2212 by 1659 pixels, color fundus photograph, FOV: 45 degrees — 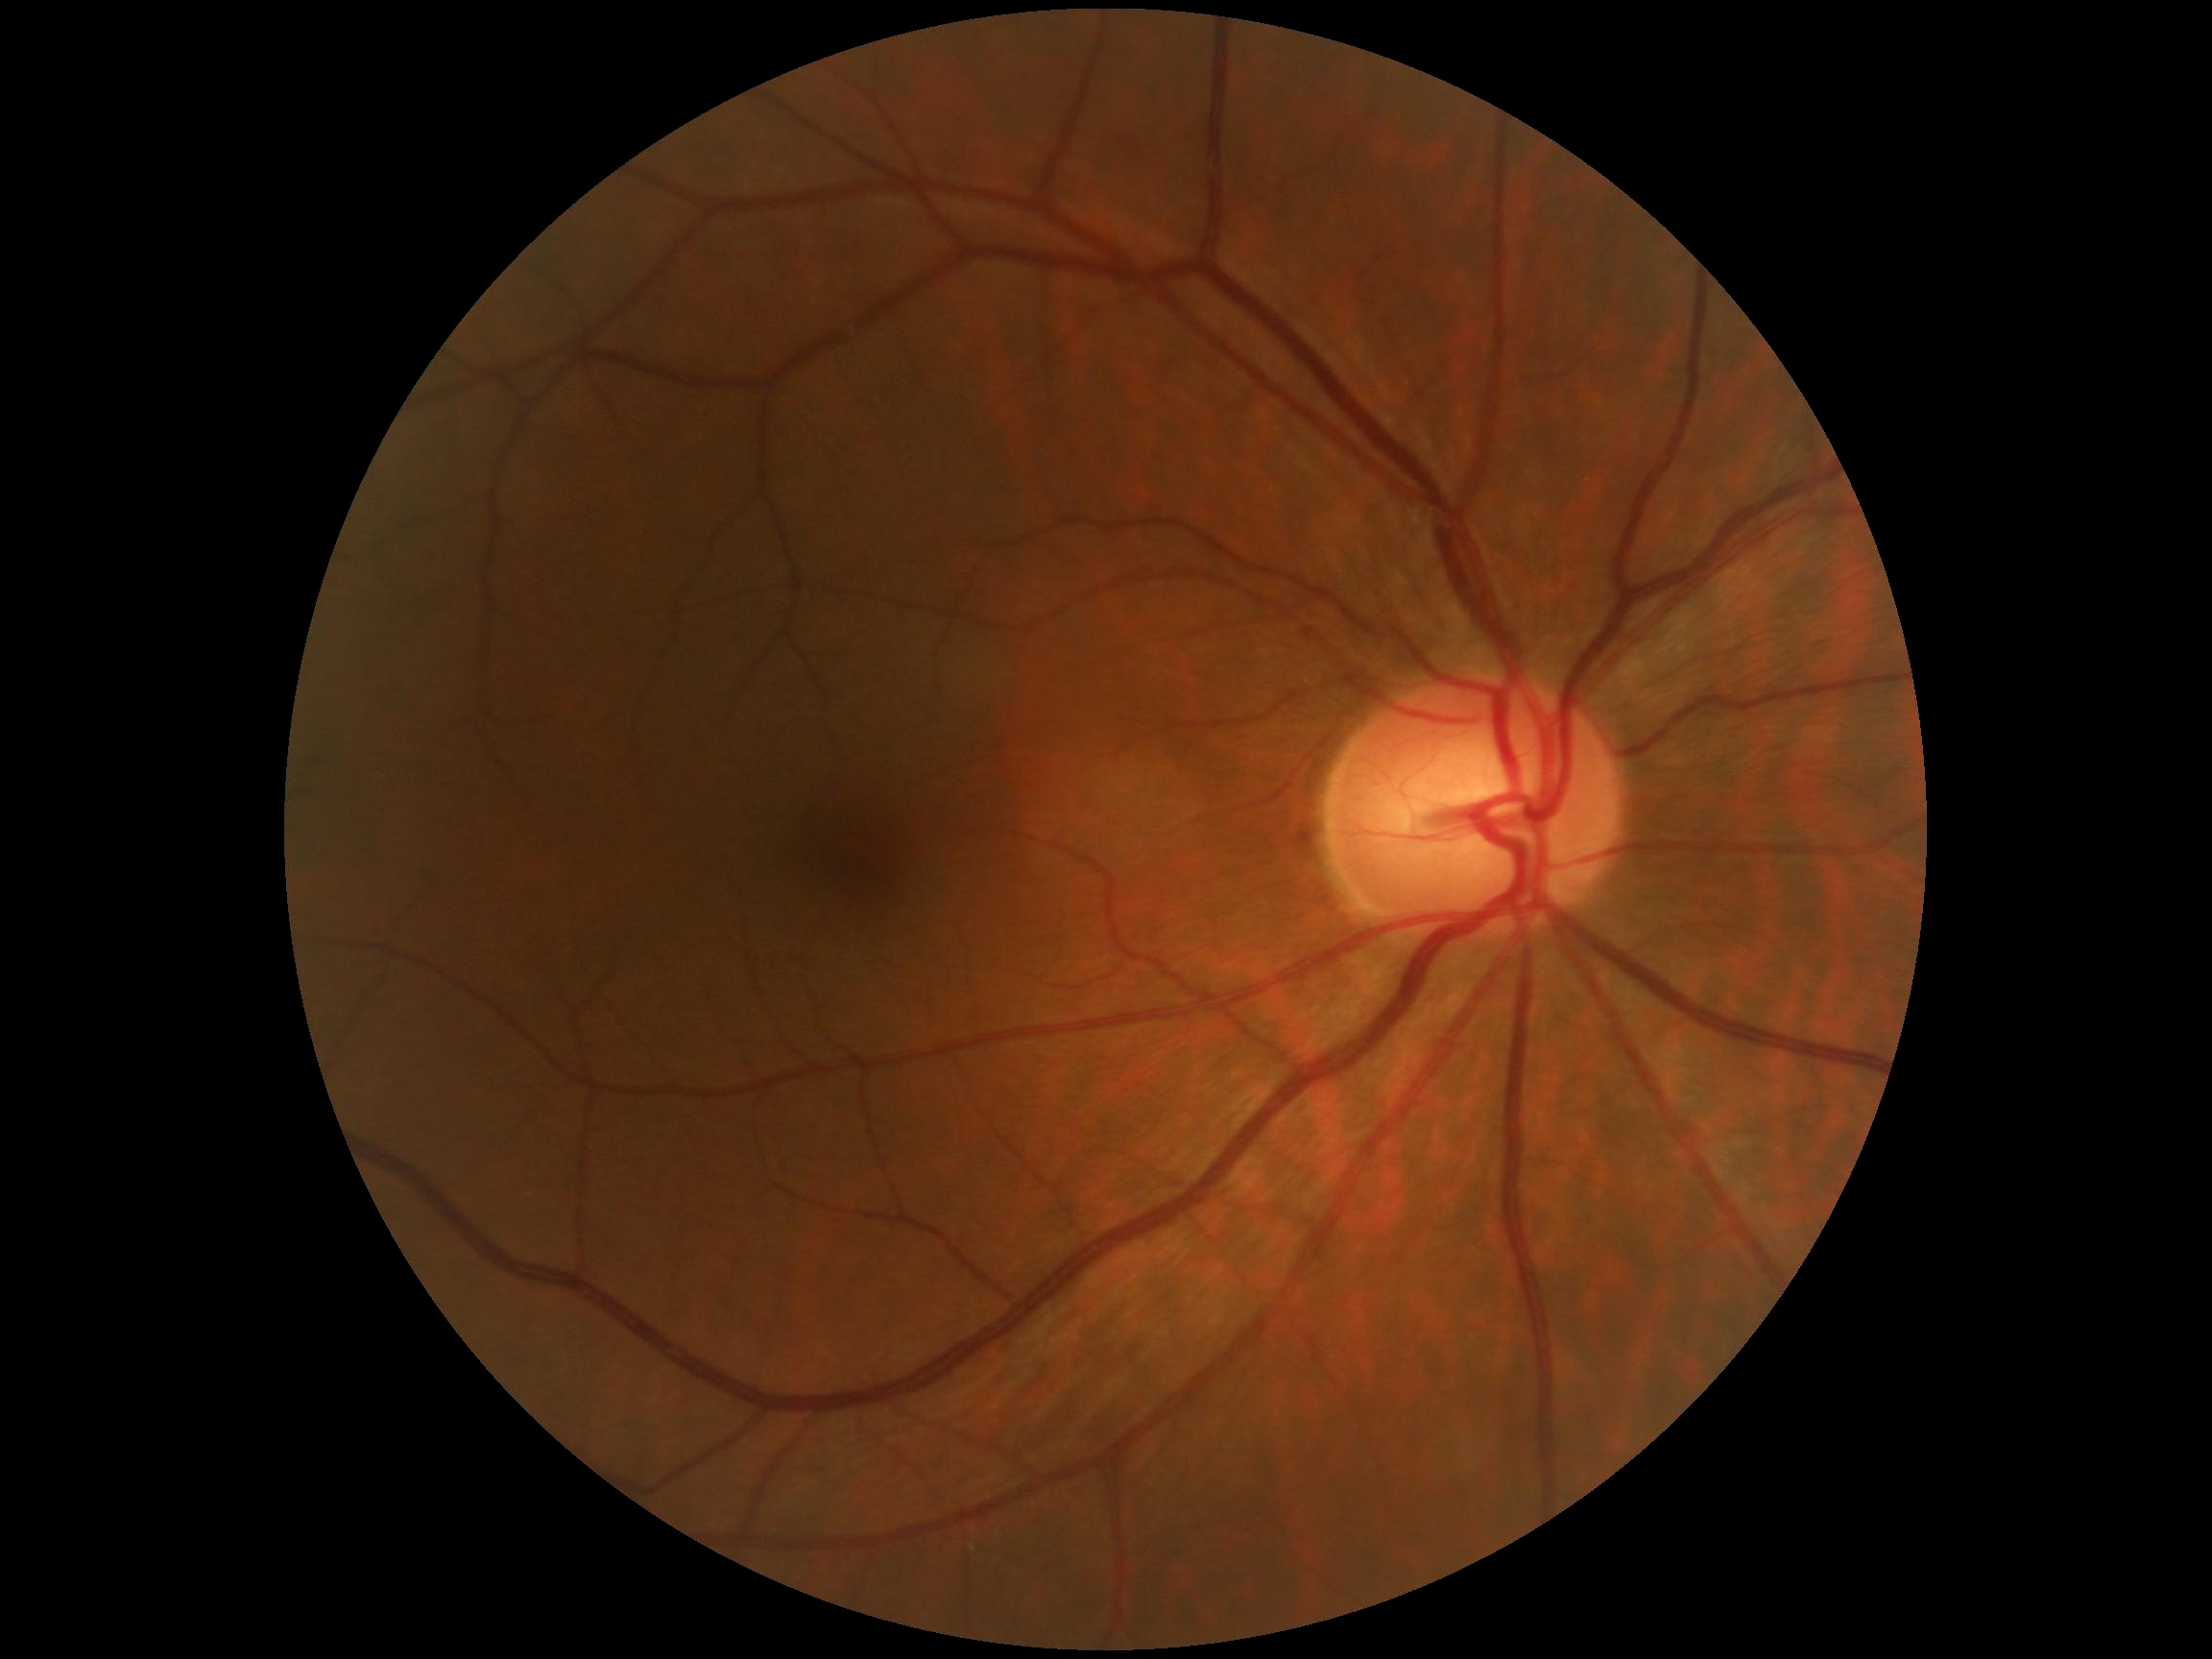
DR: 0/4.